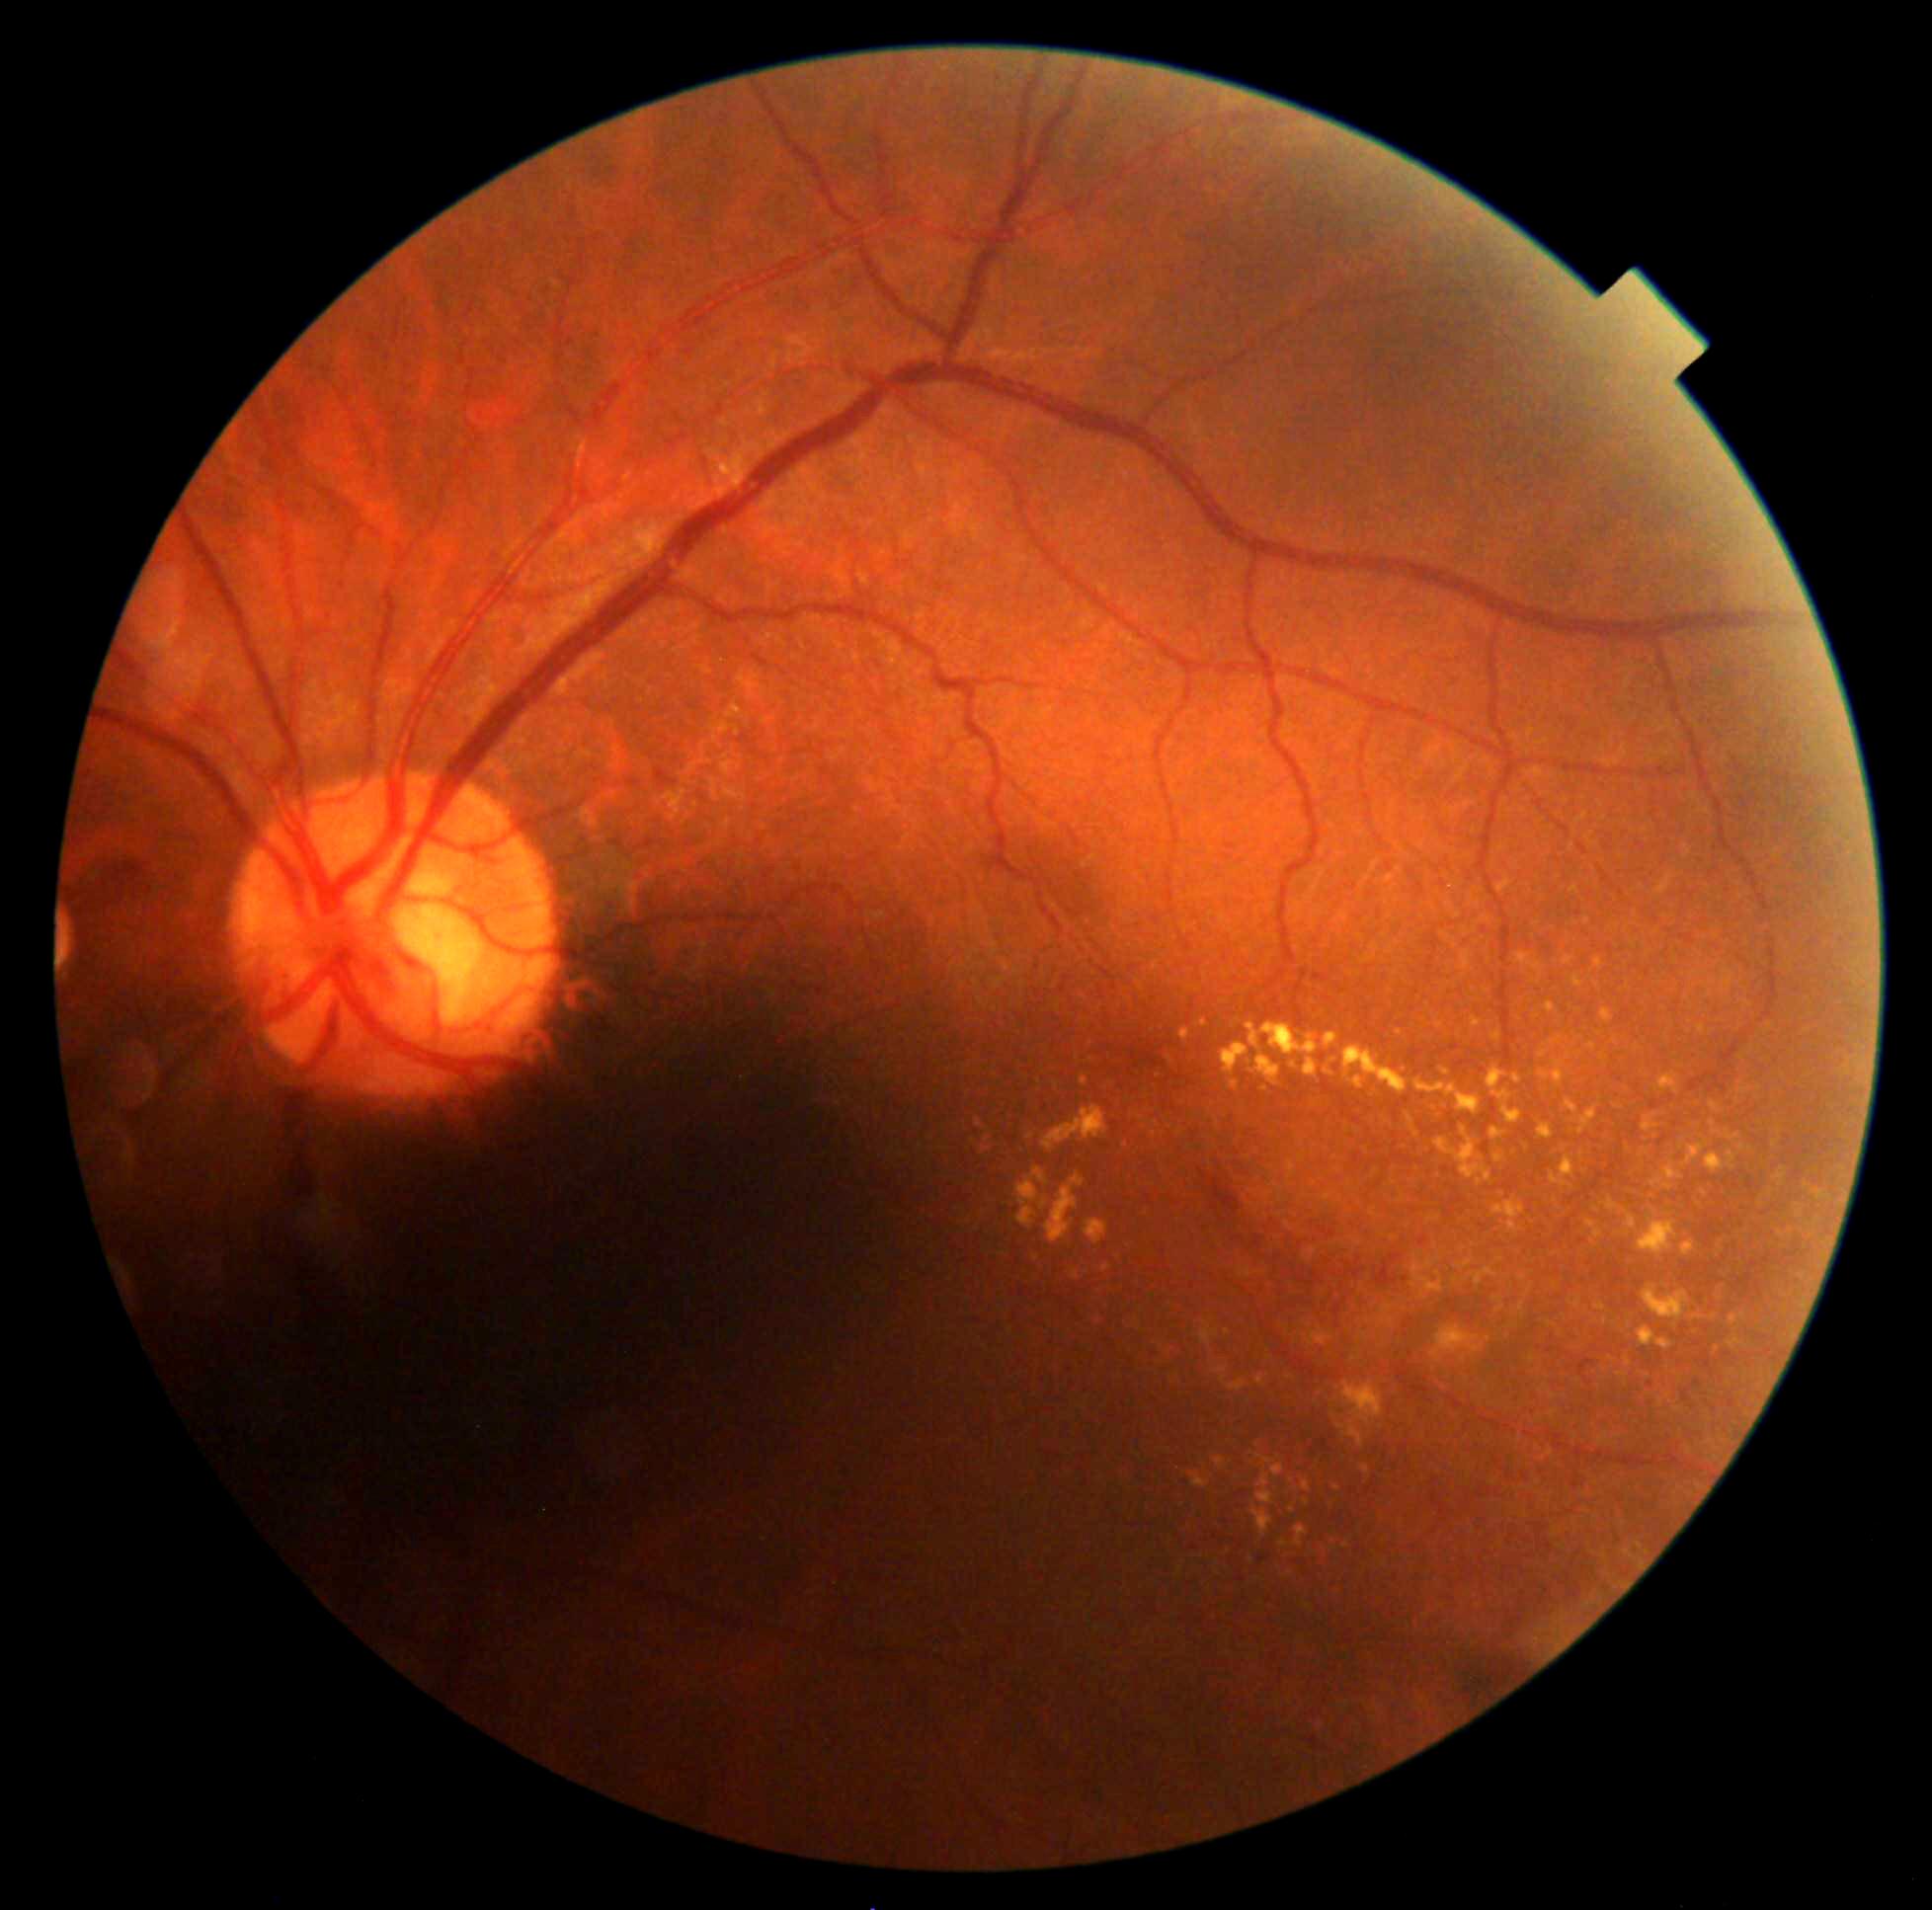
Diabetic retinopathy grade: 2/4
Lesions identified (partial list):
soft exudates: none detected
microaneurysms (more not shown): l=1584, t=1378, r=1593, b=1387 | l=1160, t=1042, r=1172, b=1053 | l=1198, t=1167, r=1241, b=1216 | l=1683, t=1390, r=1691, b=1402 | l=1131, t=1042, r=1167, b=1071 | l=1257, t=1556, r=1269, b=1563 | l=1579, t=1359, r=1595, b=1378
Microaneurysms (small, approximate centers) near x=1697, y=1384 | x=1692, y=1407 | x=1651, y=1386 | x=1131, y=1071
hemorrhages: none detected
hard exudates (more not shown): l=1594, t=958, r=1603, b=971 | l=1179, t=1030, r=1190, b=1042 | l=1572, t=974, r=1585, b=989 | l=1325, t=1059, r=1337, b=1078 | l=1538, t=1051, r=1547, b=1059 | l=1230, t=1081, r=1239, b=1090 | l=1845, t=1193, r=1848, b=1205 | l=1085, t=1220, r=1108, b=1246 | l=1432, t=1325, r=1485, b=1363 | l=1637, t=1327, r=1674, b=1350 | l=1247, t=1022, r=1320, b=1087 | l=1698, t=1028, r=1707, b=1035 | l=1643, t=1114, r=1660, b=1134
Hard exudates (small, approximate centers) near x=1630, y=1326 | x=1481, y=1159 | x=1536, y=1017 | x=1771, y=1193 | x=1654, y=1212 | x=1264, y=1089